45° FOV
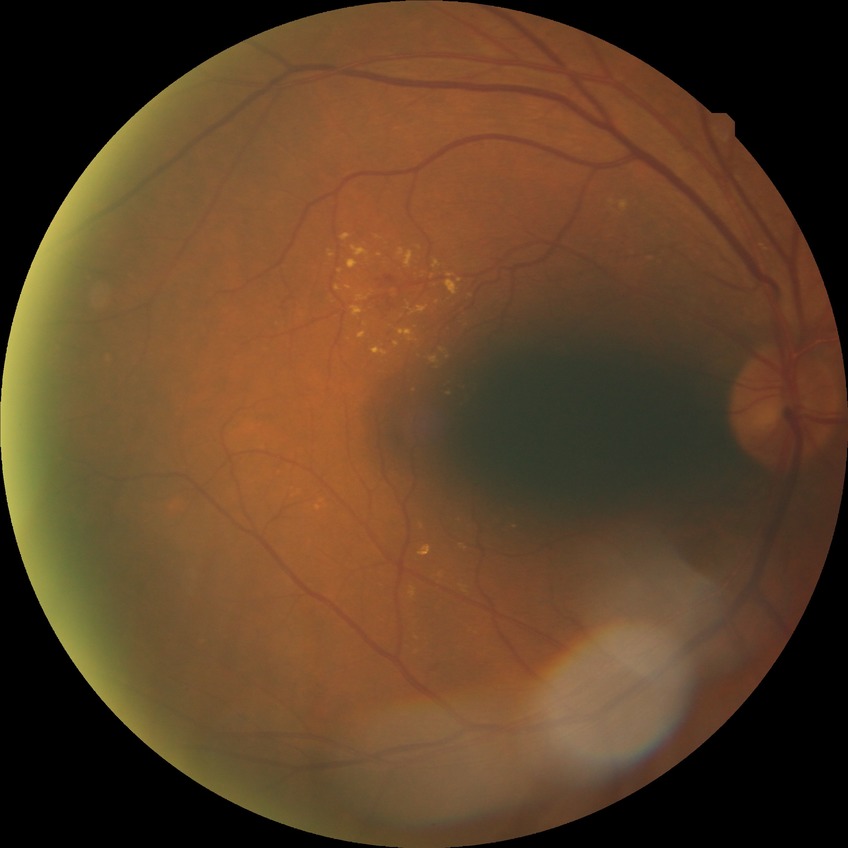

{"davis_grade": "SDR (simple diabetic retinopathy)"}